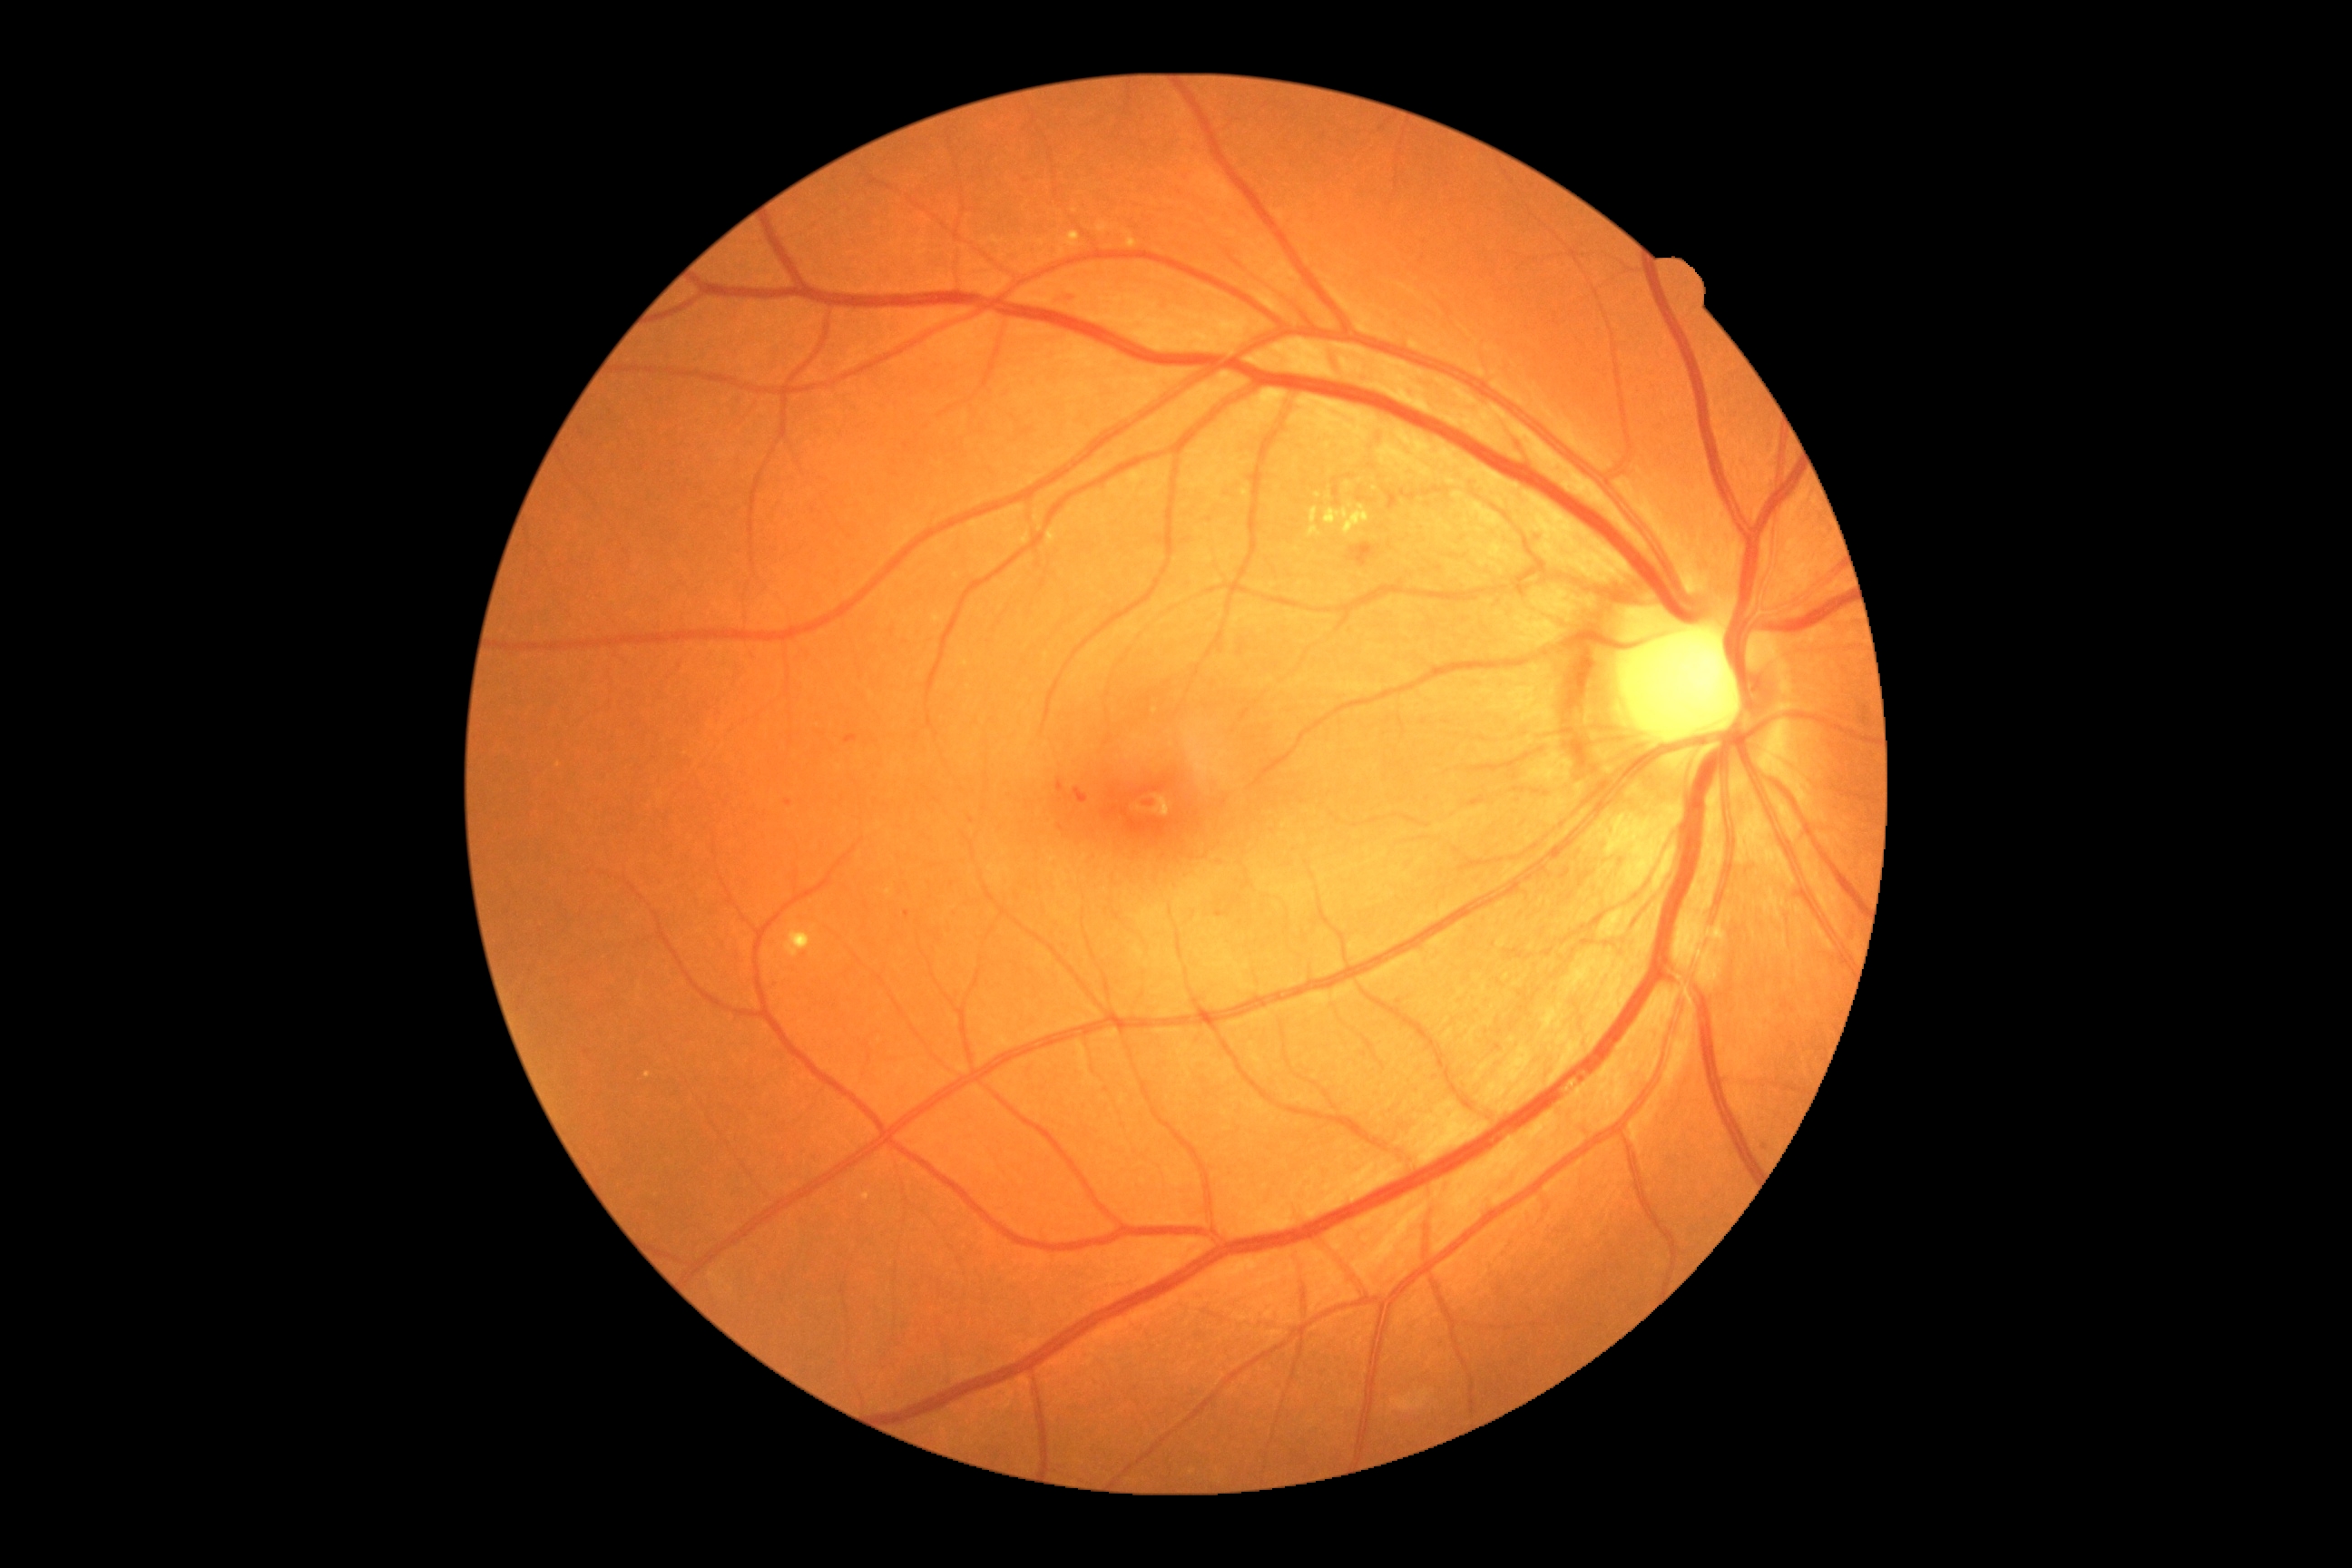 DR: moderate non-proliferative diabetic retinopathy (grade 2); non-proliferative diabetic retinopathy
Lesions identified (partial list):
MAs (subset) = (1357, 496, 1366, 502) | (1400, 489, 1416, 502) | (905, 910, 910, 919) | (785, 799, 792, 807) | (1059, 291, 1072, 300) | (1215, 910, 1230, 917) | (1333, 478, 1340, 498) | (1057, 779, 1068, 798) | (845, 734, 859, 745) | (1387, 493, 1398, 511) | (1536, 534, 1545, 544) | (1070, 789, 1088, 803) | (1422, 487, 1442, 496) | (1142, 801, 1155, 808)
Additional small MAs near point(1372, 502) | point(1349, 476) | point(1429, 505) | point(1425, 723) | point(1337, 502)
SEs = absent
EXs = (1097, 222, 1115, 233) | (1124, 230, 1137, 250) | (861, 1193, 870, 1202) | (1064, 231, 1081, 248) | (1308, 507, 1322, 538) | (785, 926, 814, 959) | (1324, 505, 1369, 536)
Additional small EXs near point(1329, 498) | point(1351, 507) | point(648, 1075) | point(1318, 498)
HEs = (1348, 544, 1377, 567)